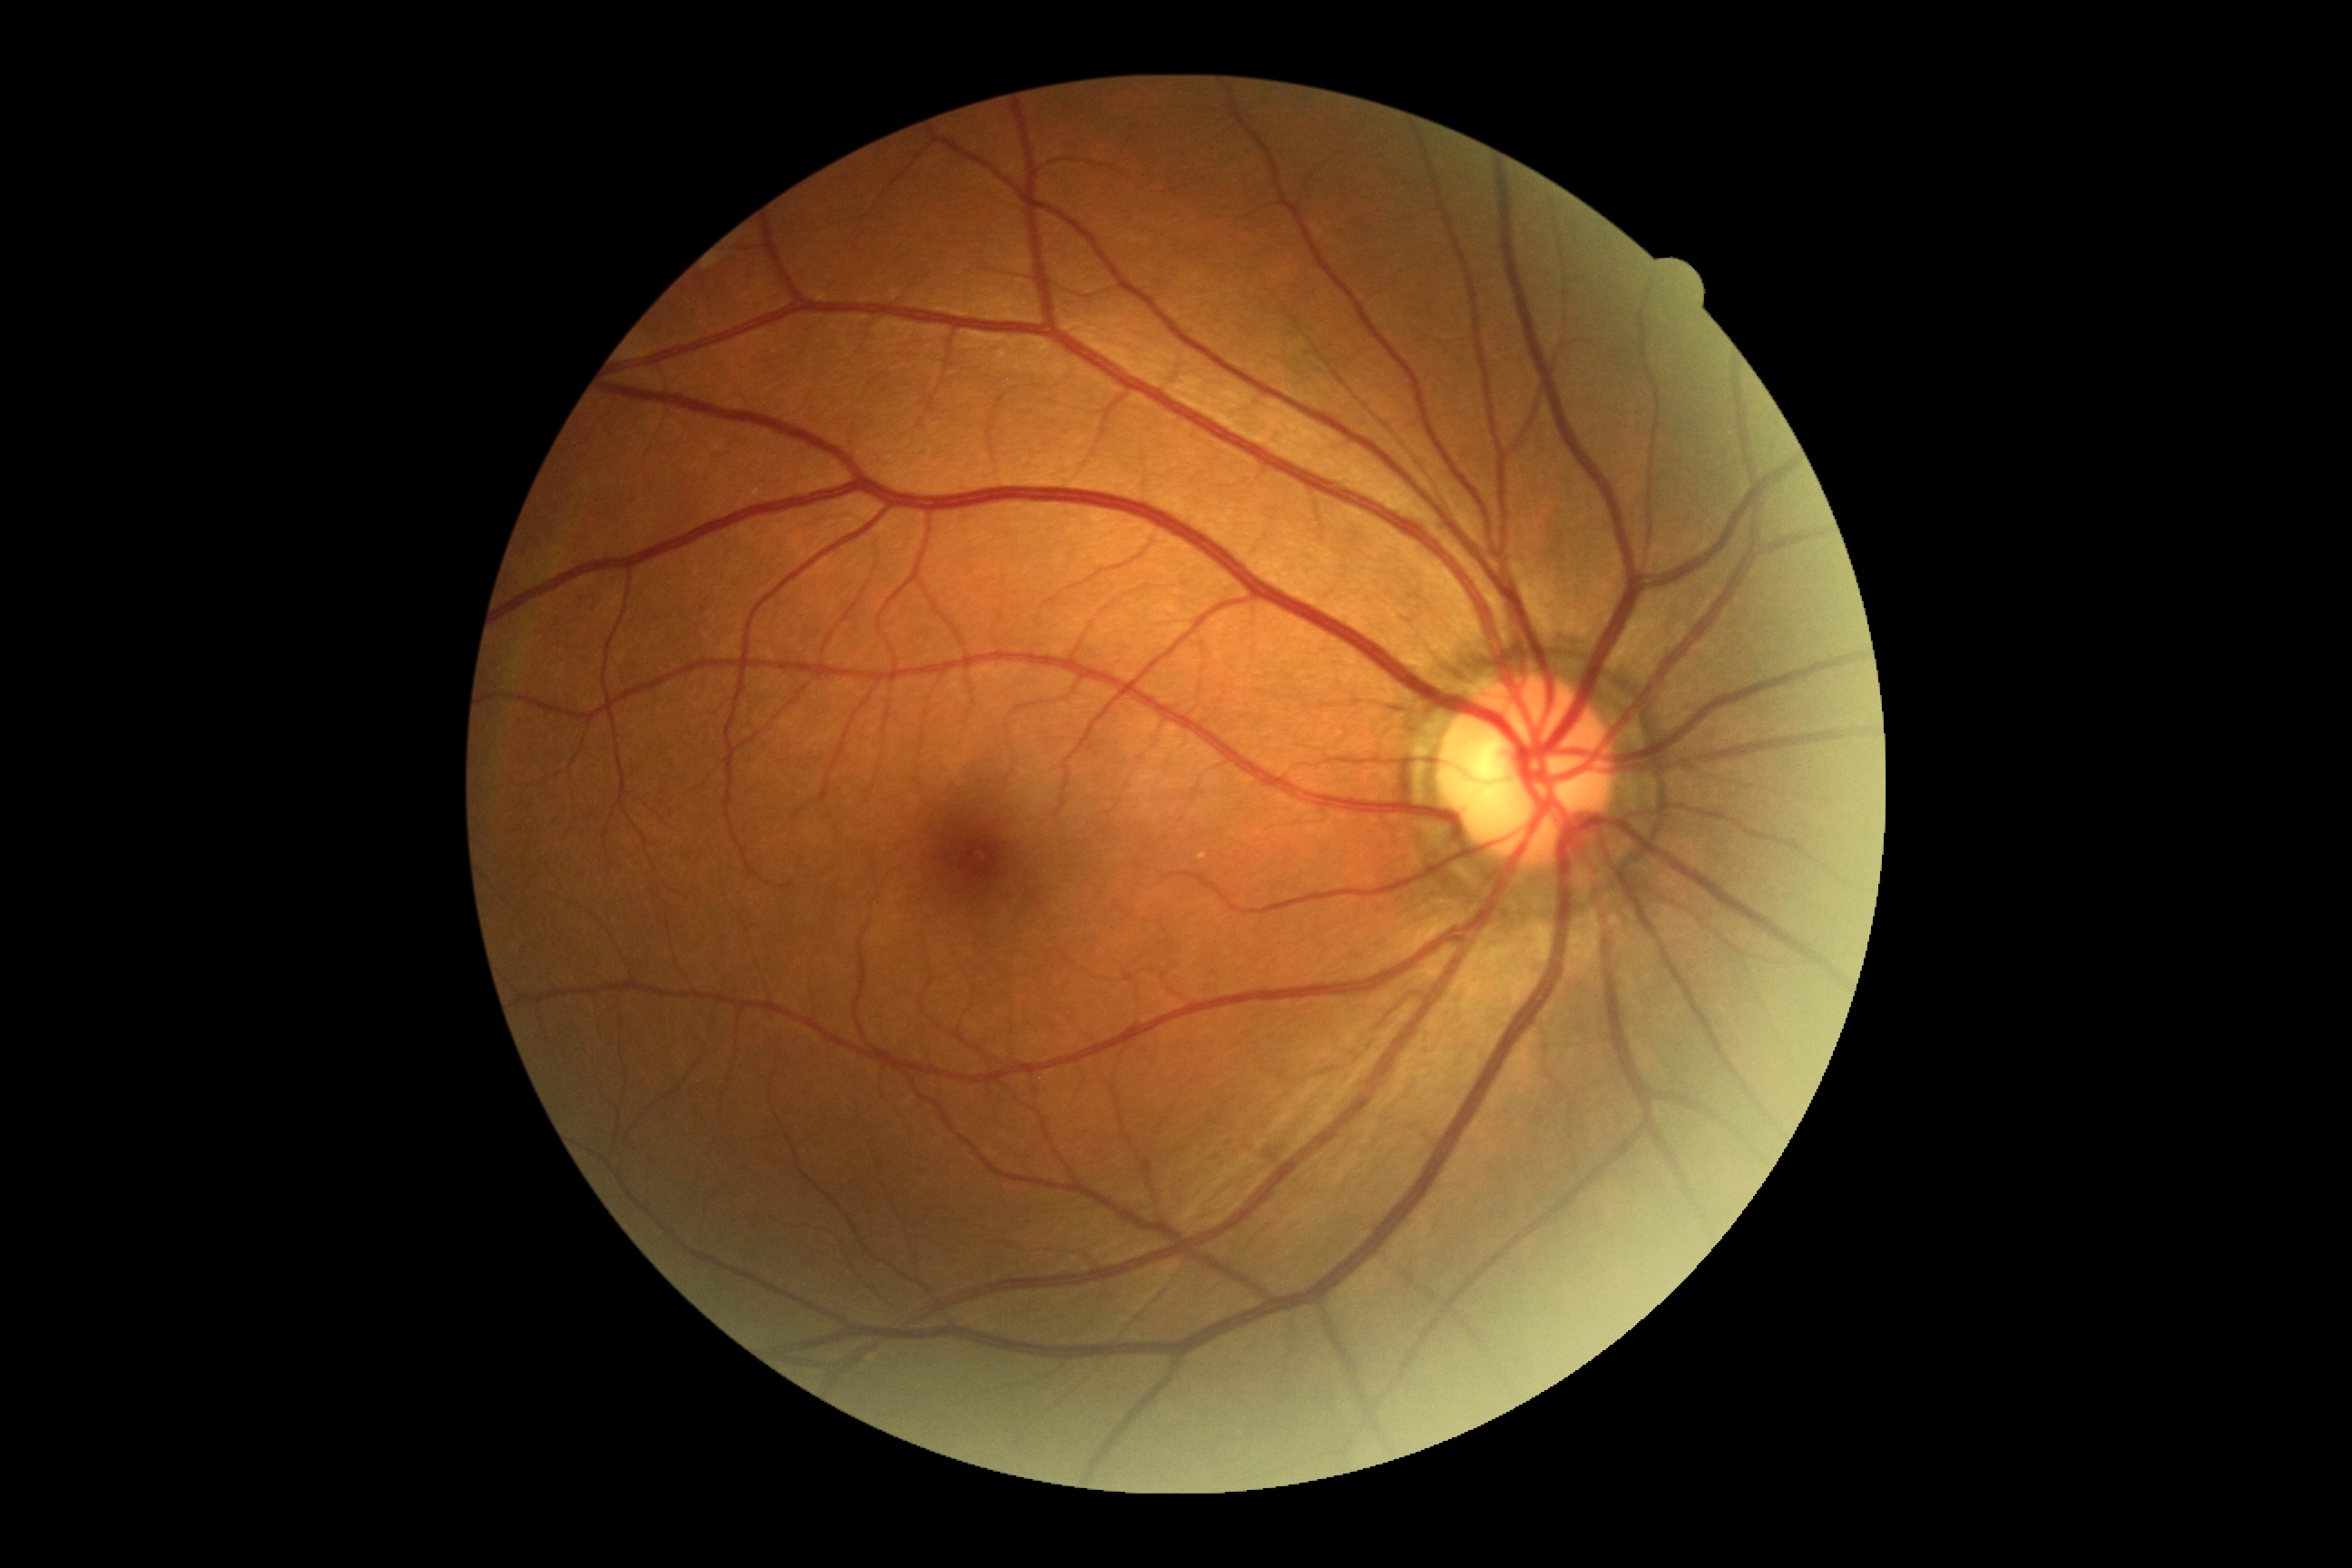
No DR findings. DR stage: 0/4.